2352x1568px; 45° FOV — 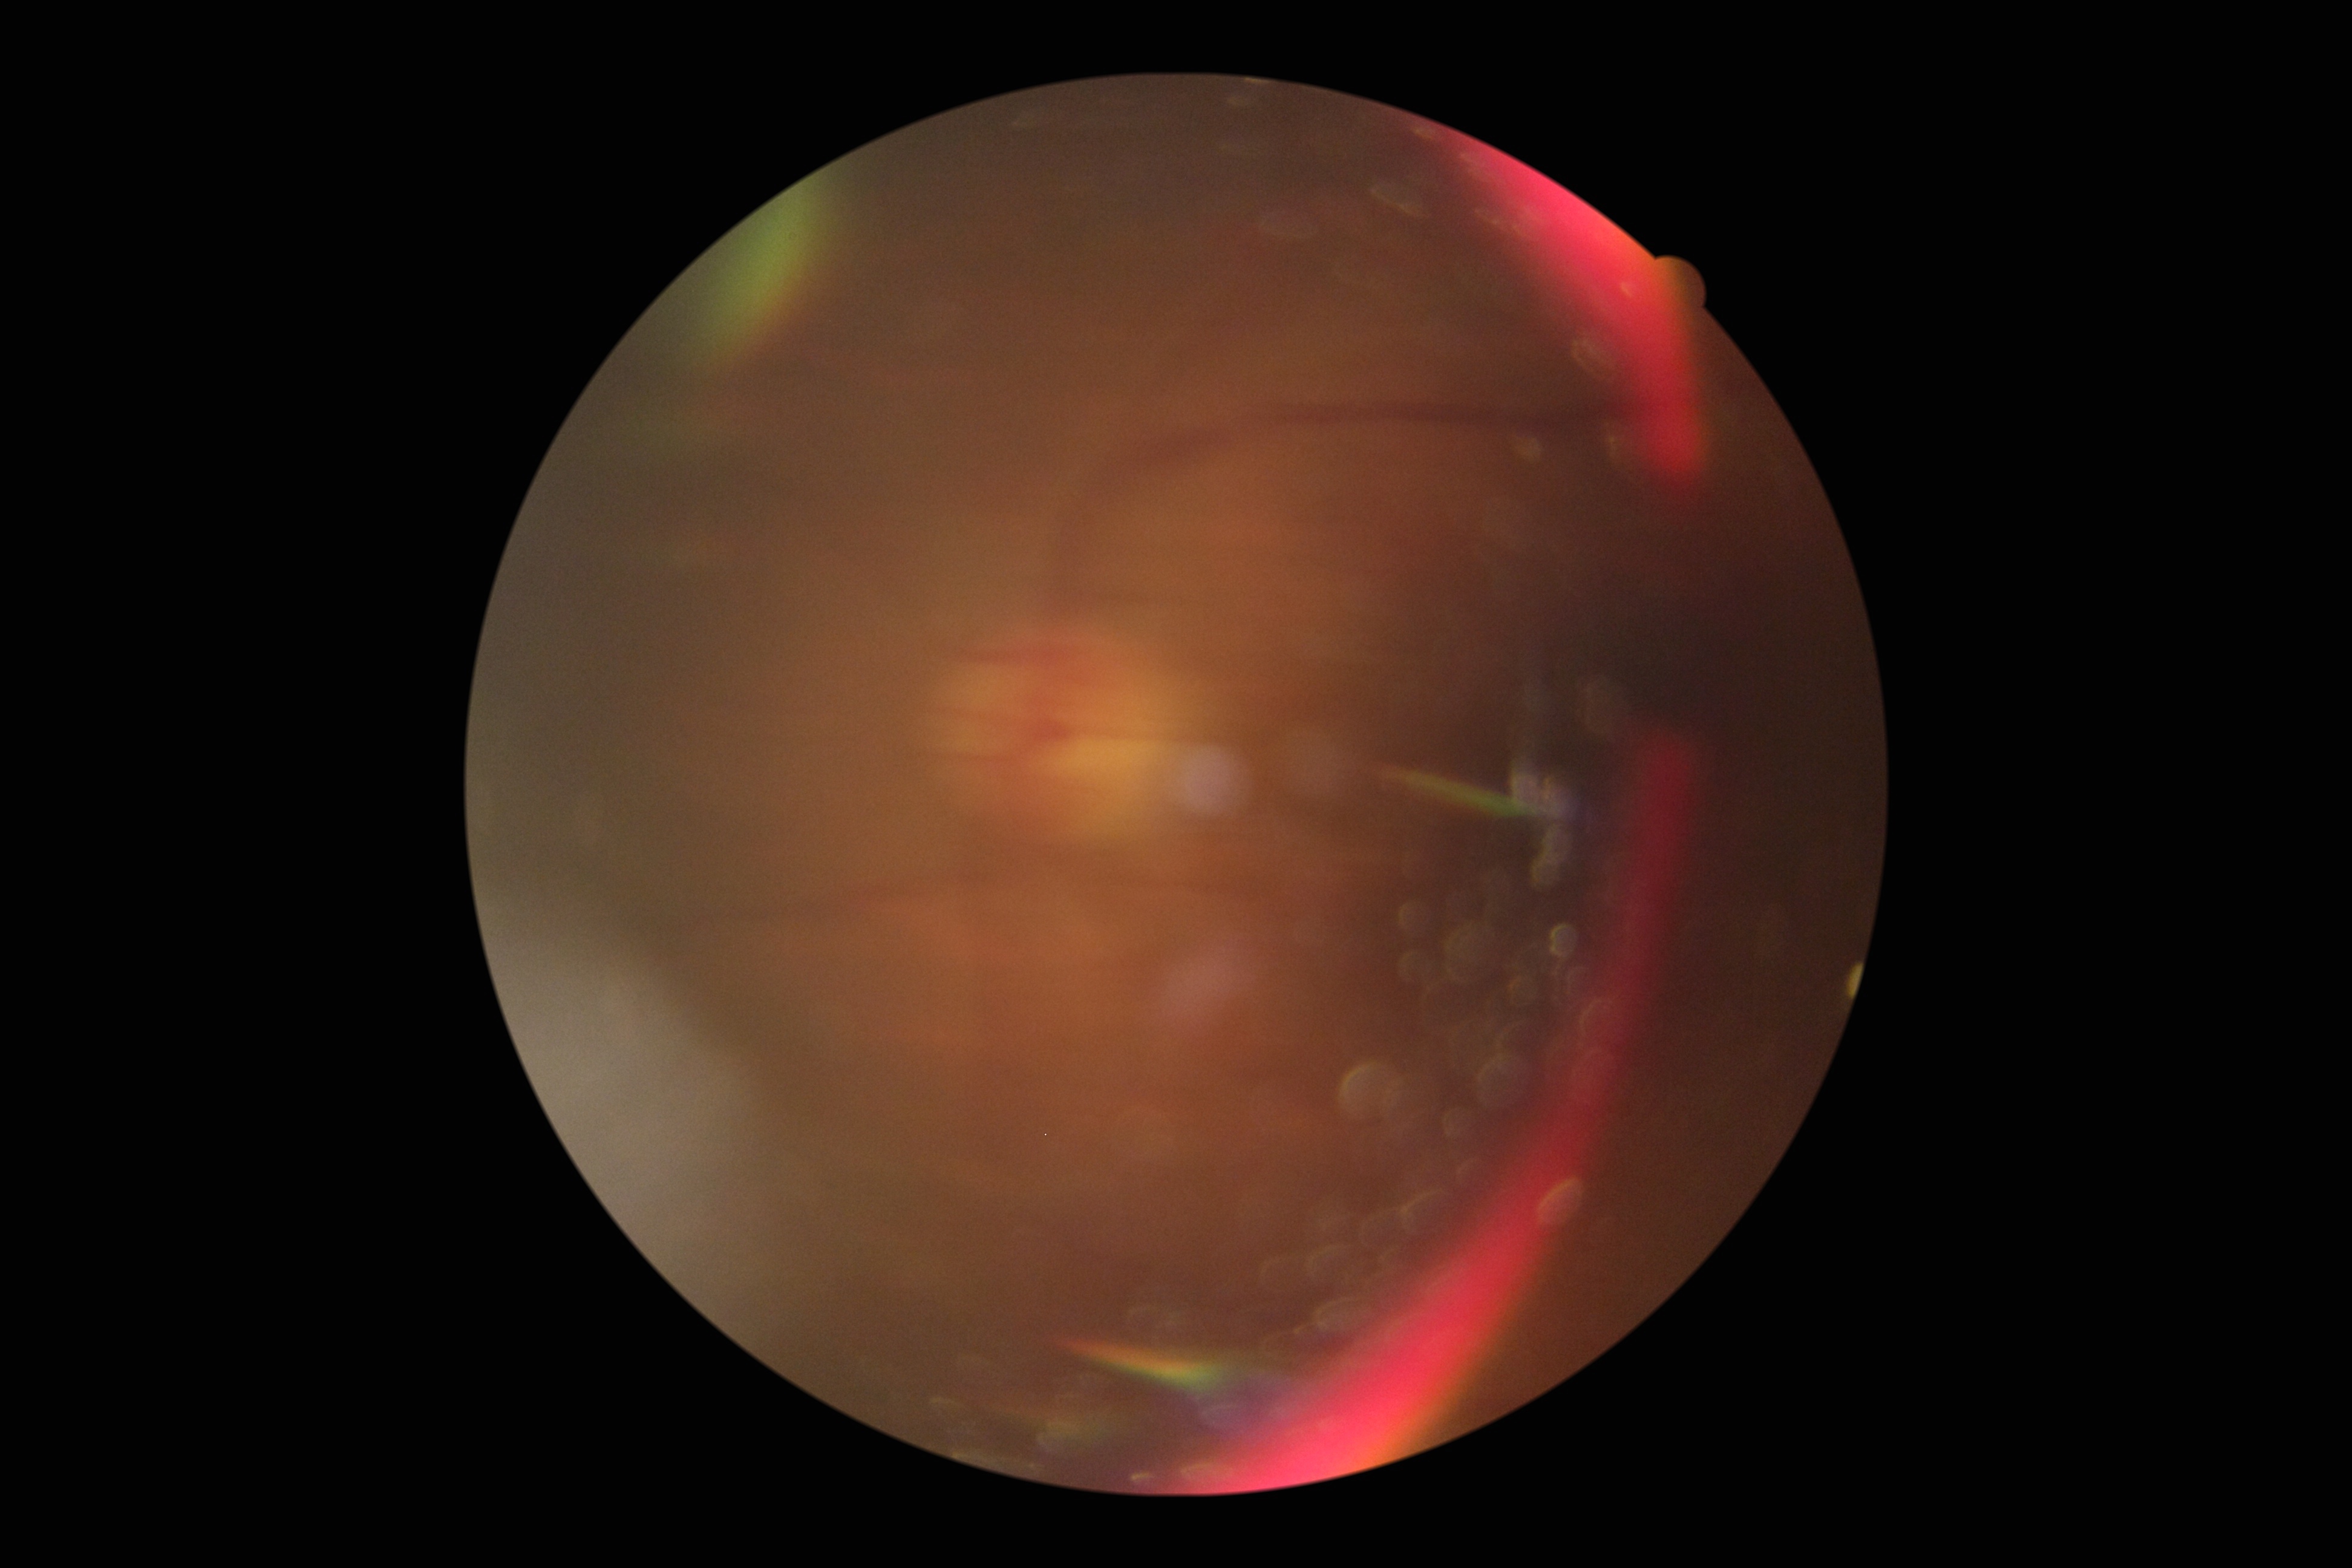
* DR severity — ungradable due to poor image quality